45° field of view; graded on the modified Davis scale.
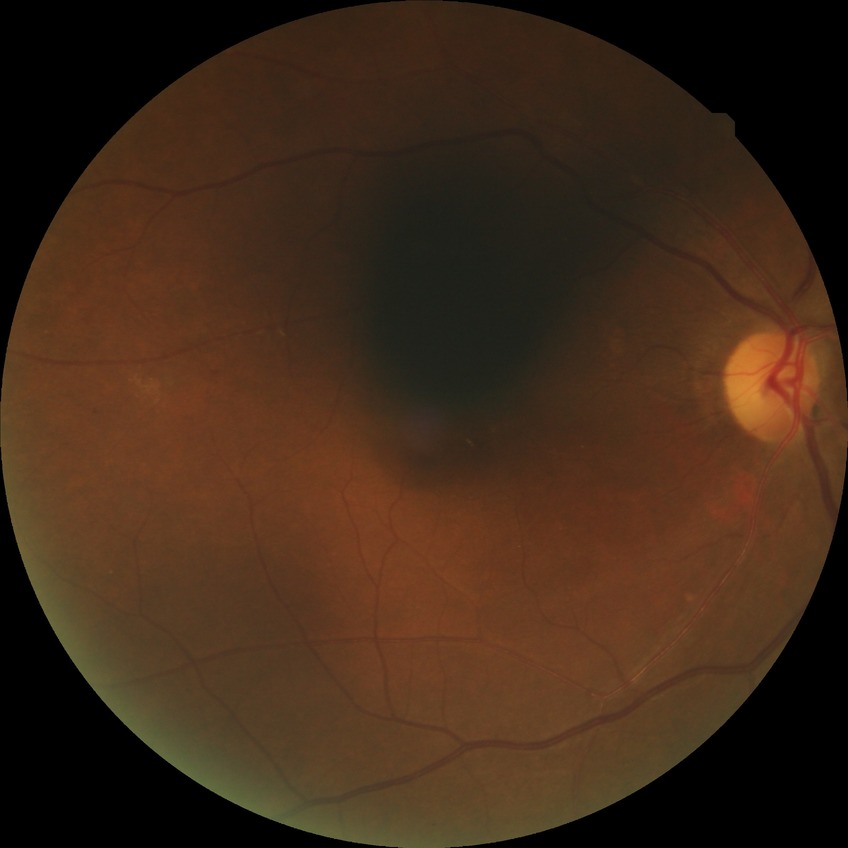 diabetic retinopathy stage: pre-proliferative diabetic retinopathy.